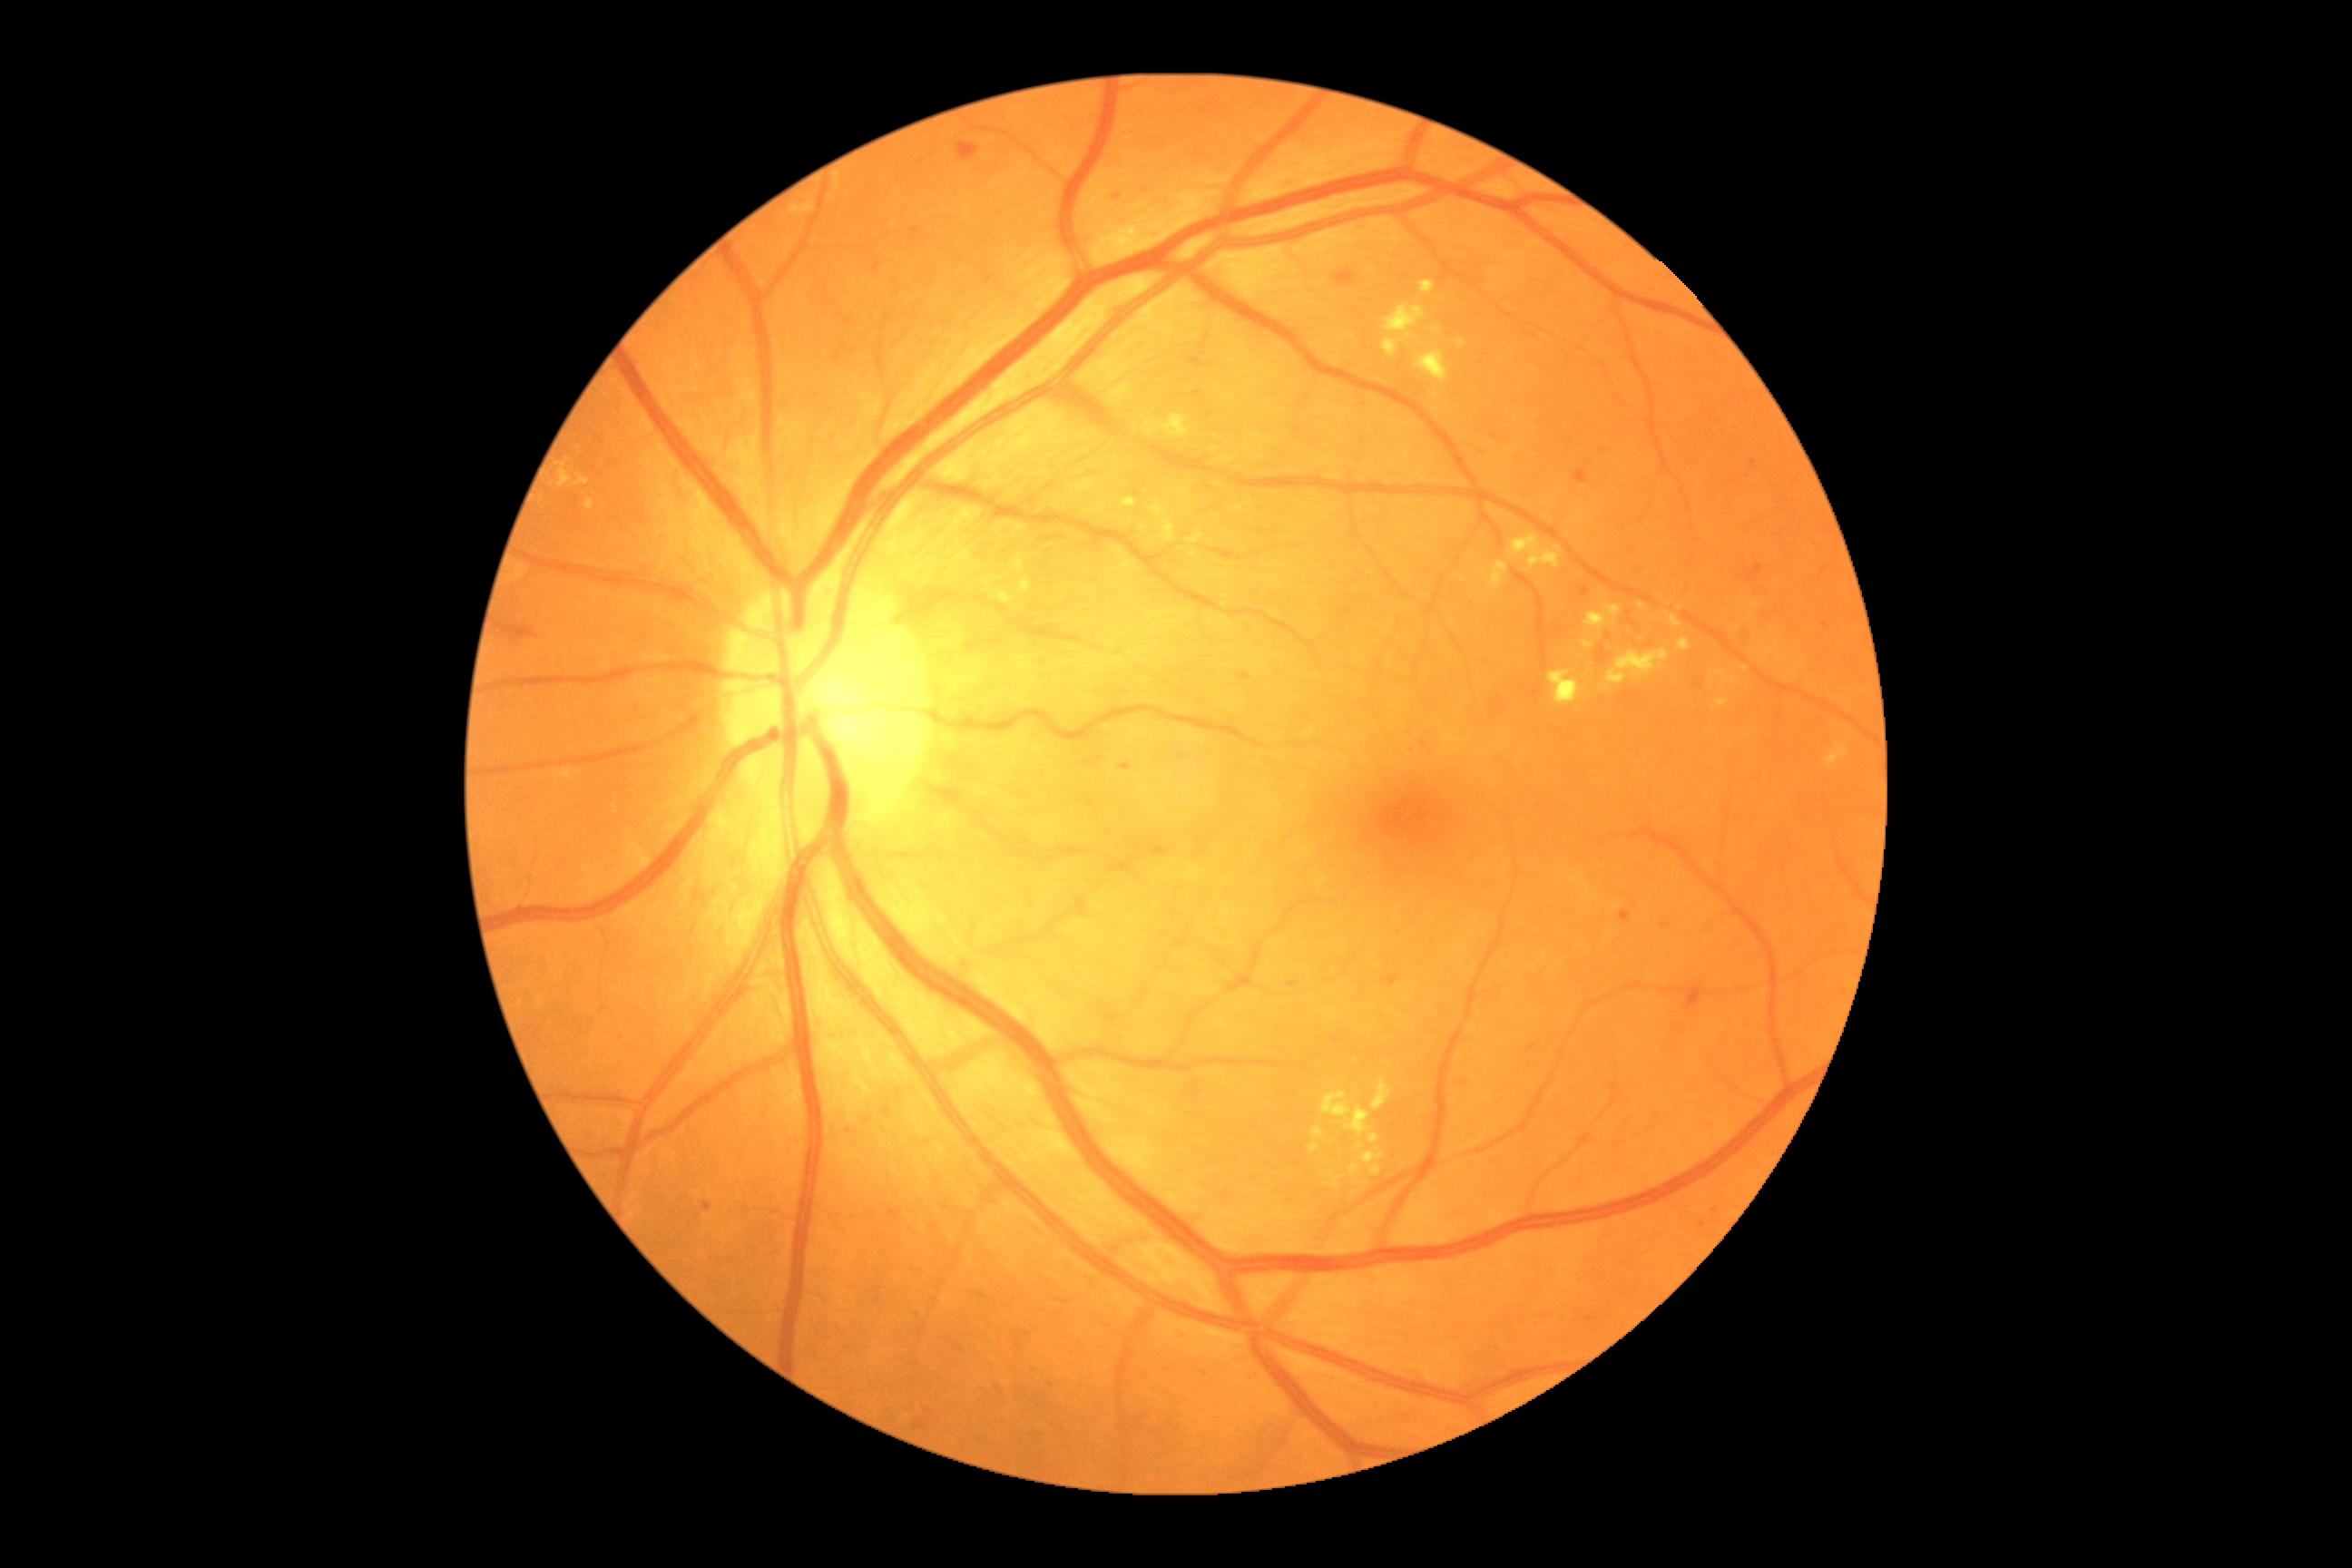 <lesions partial="true">
  <dr_grade>2</dr_grade>
  <ex partial="true"><box>1351,1166,1362,1175</box> | <box>1420,280,1435,297</box> | <box>1121,498,1137,507</box> | <box>1369,1133,1380,1144</box> | <box>1023,580,1030,594</box> | <box>1382,306,1426,357</box> | <box>1357,1142,1364,1152</box> | <box>1416,351,1449,384</box> | <box>1371,1079,1393,1112</box> | <box>790,202,816,215</box> | <box>558,769,573,781</box> | <box>1015,554,1024,573</box> | <box>1489,562,1509,591</box></ex>
  <ex_small_centers><pt>1436,396</pt> | <pt>1216,437</pt> | <pt>1712,688</pt> | <pt>1680,609</pt></ex_small_centers>
</lesions>